CFP; image size 2352x1568.
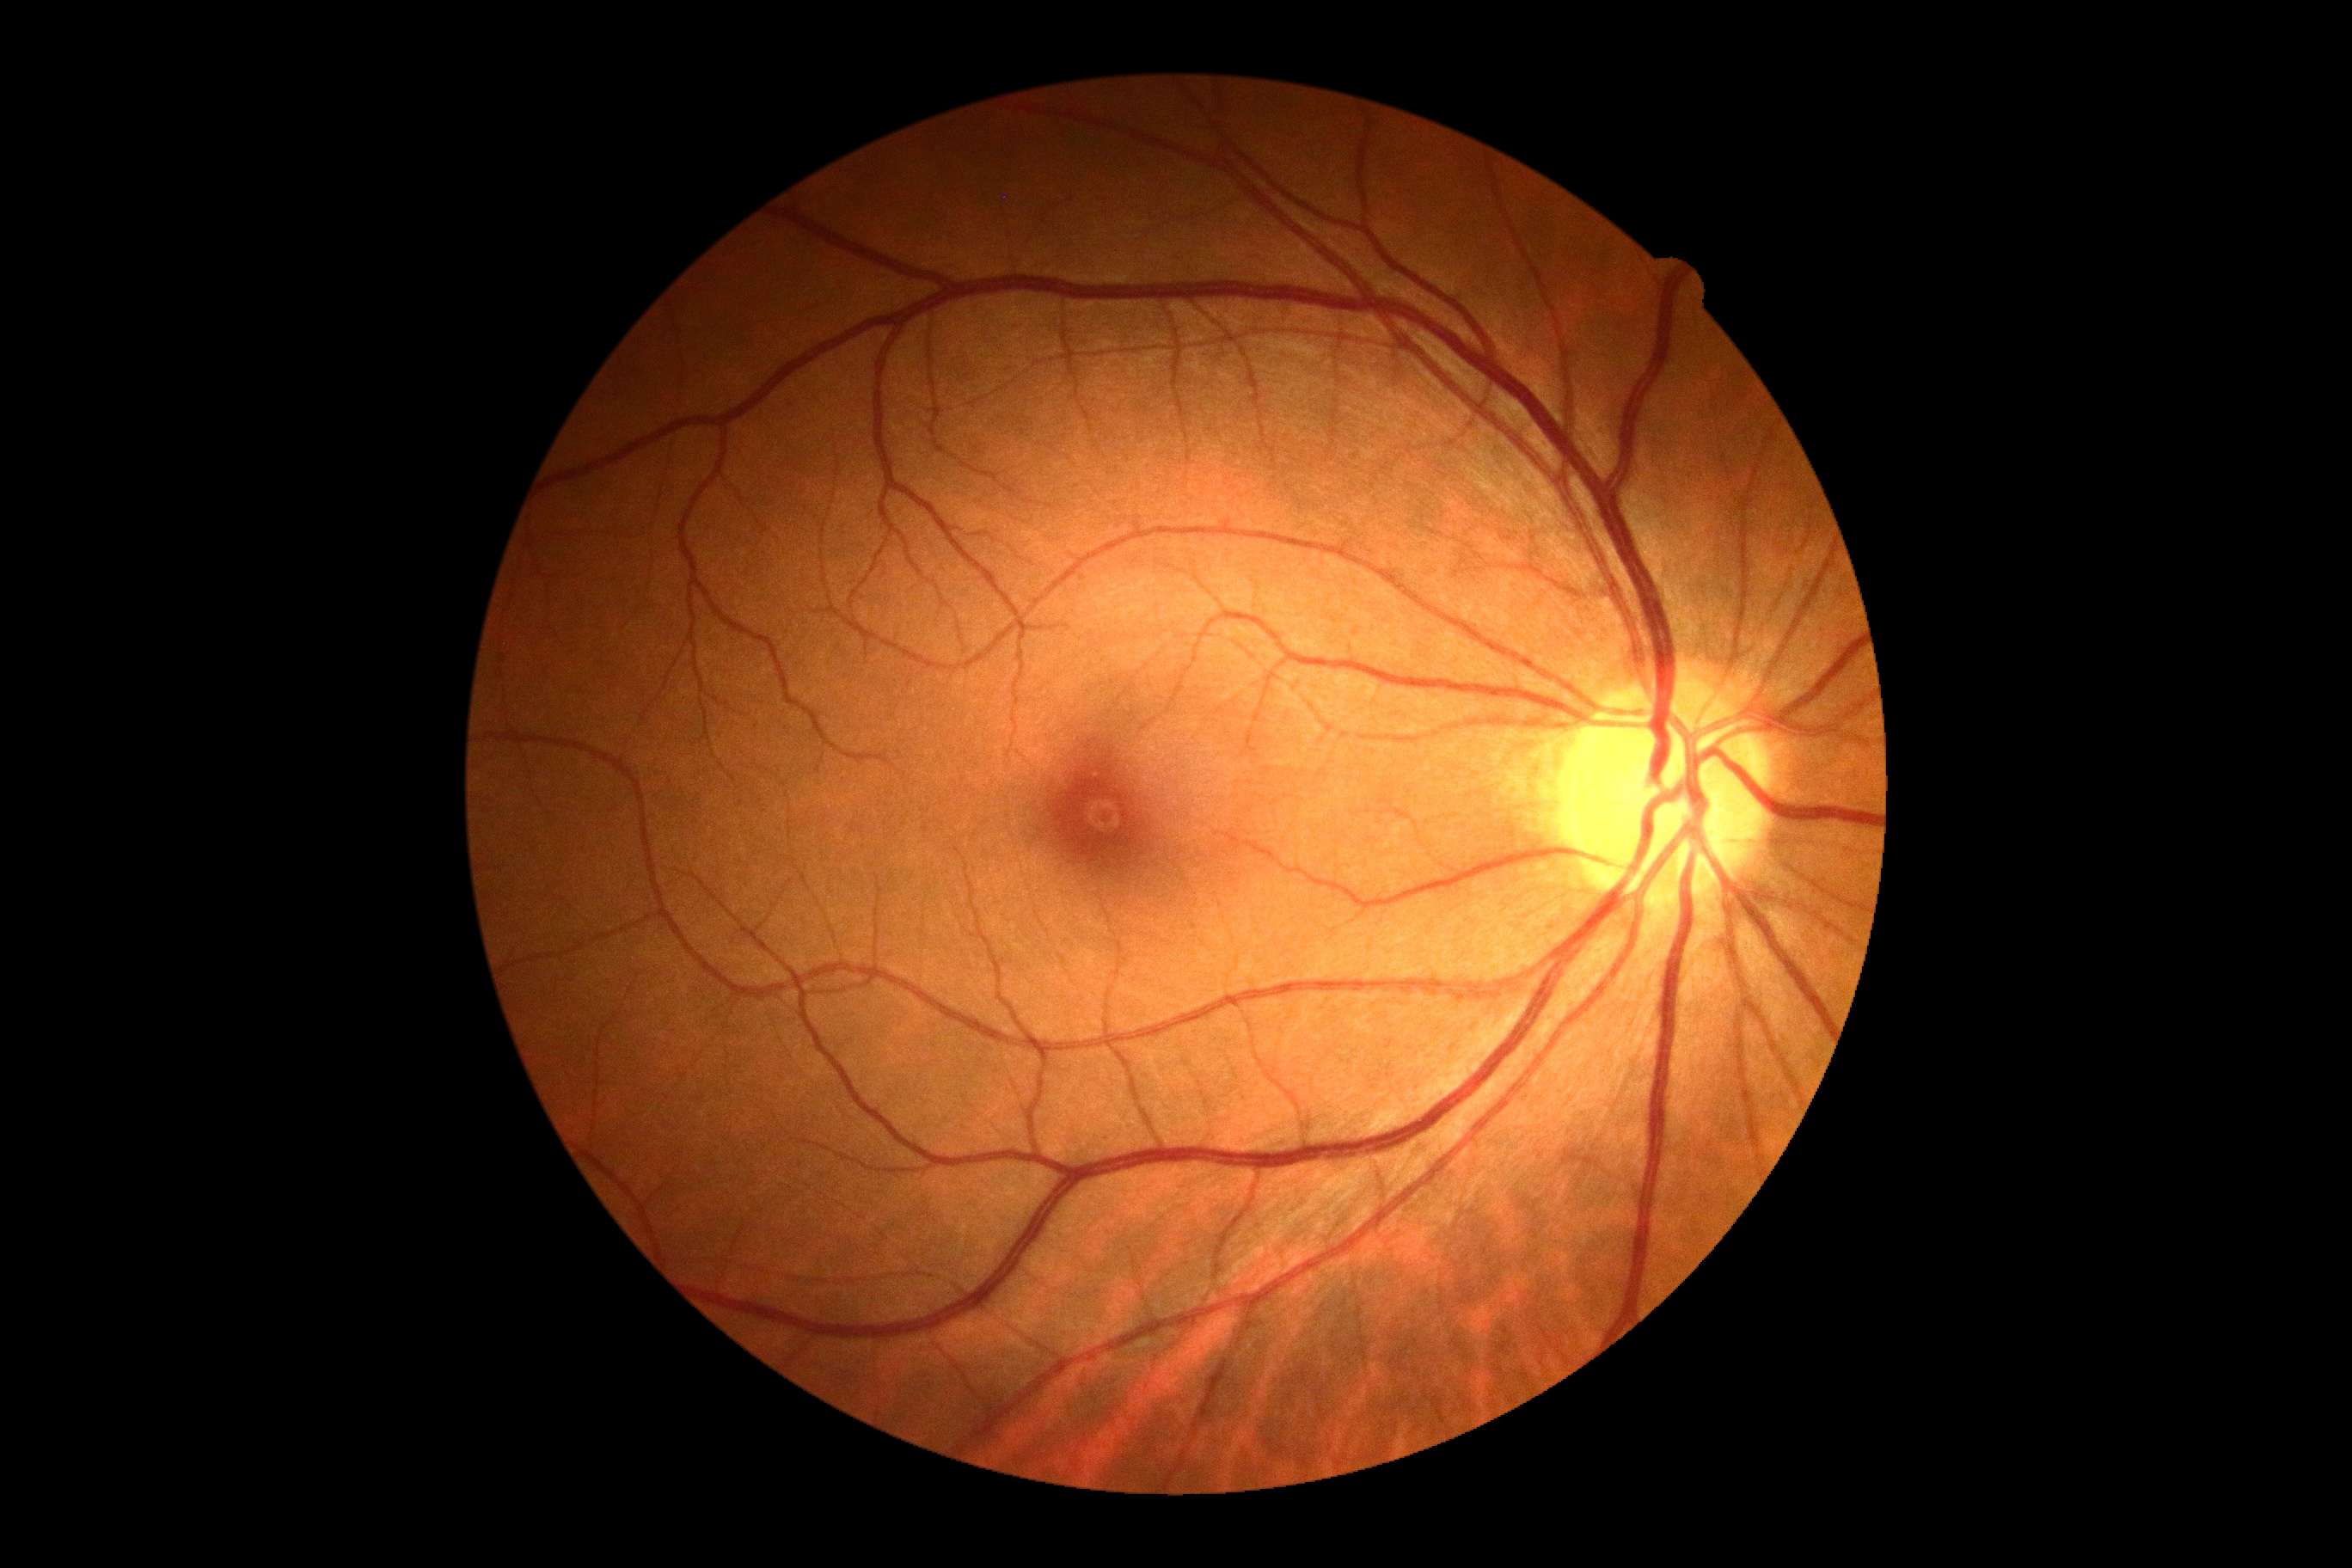

DR impression = no signs of DR
DR stage = 0